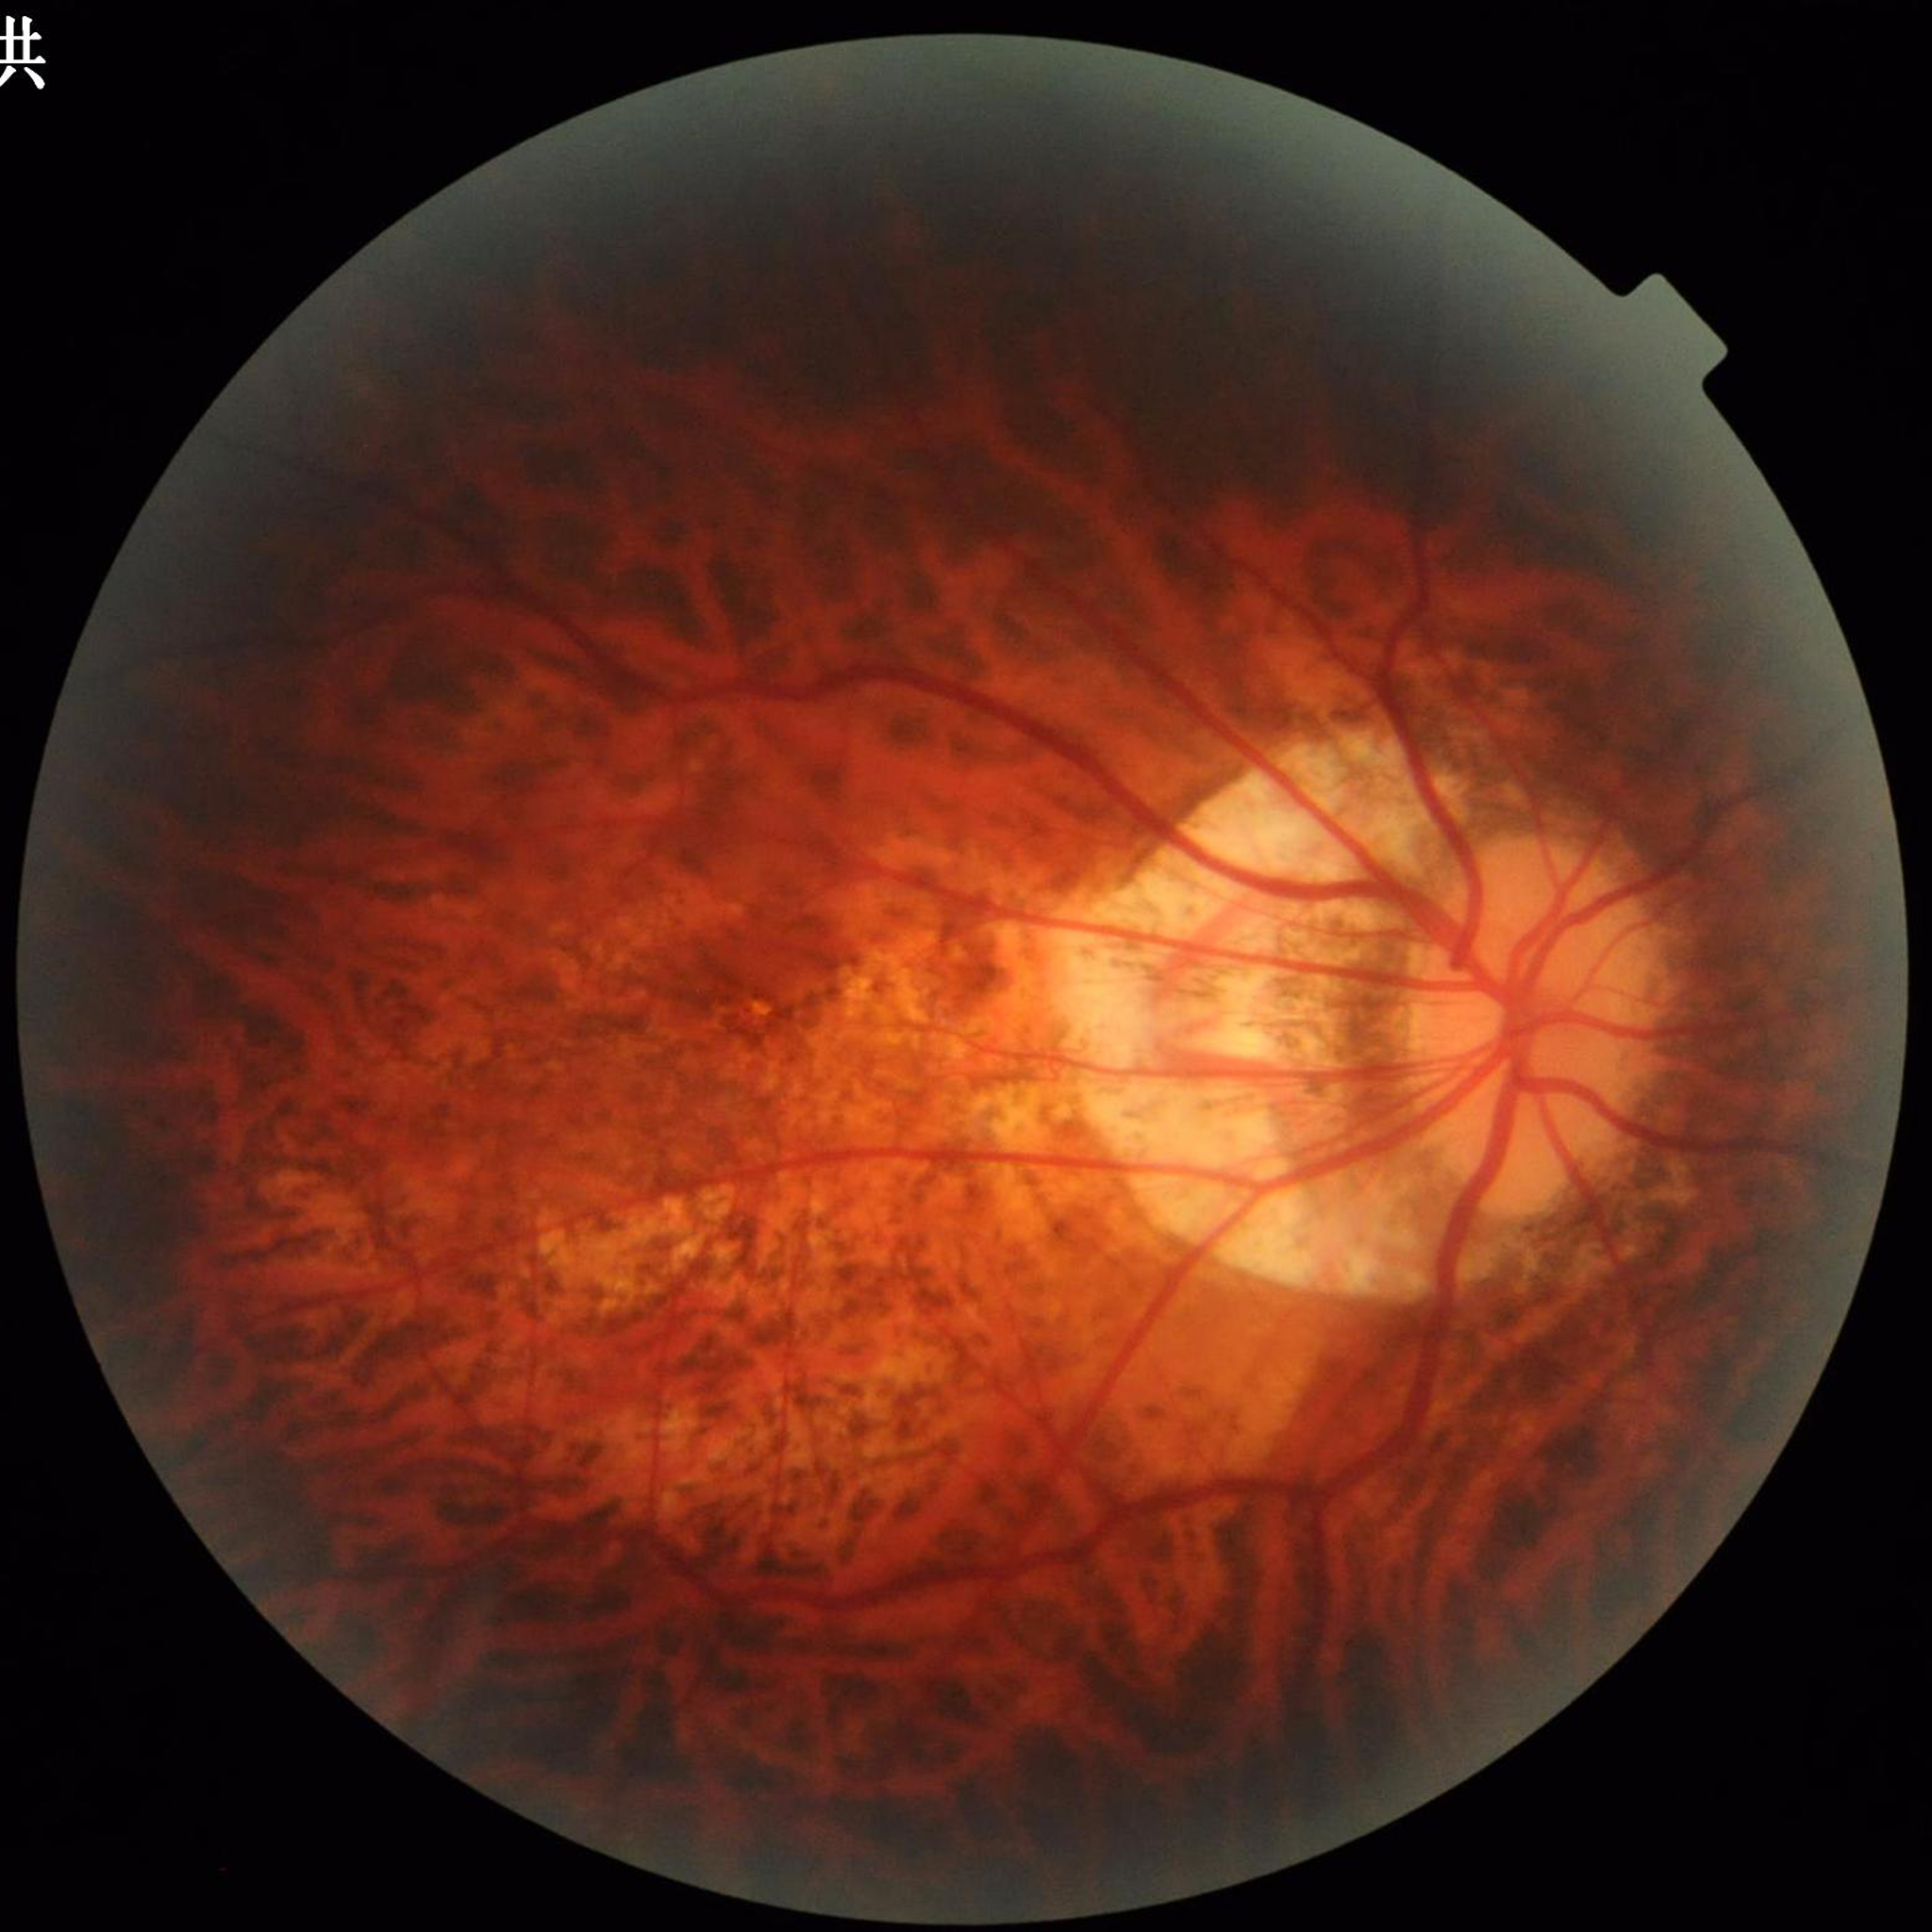 Impression: glaucoma